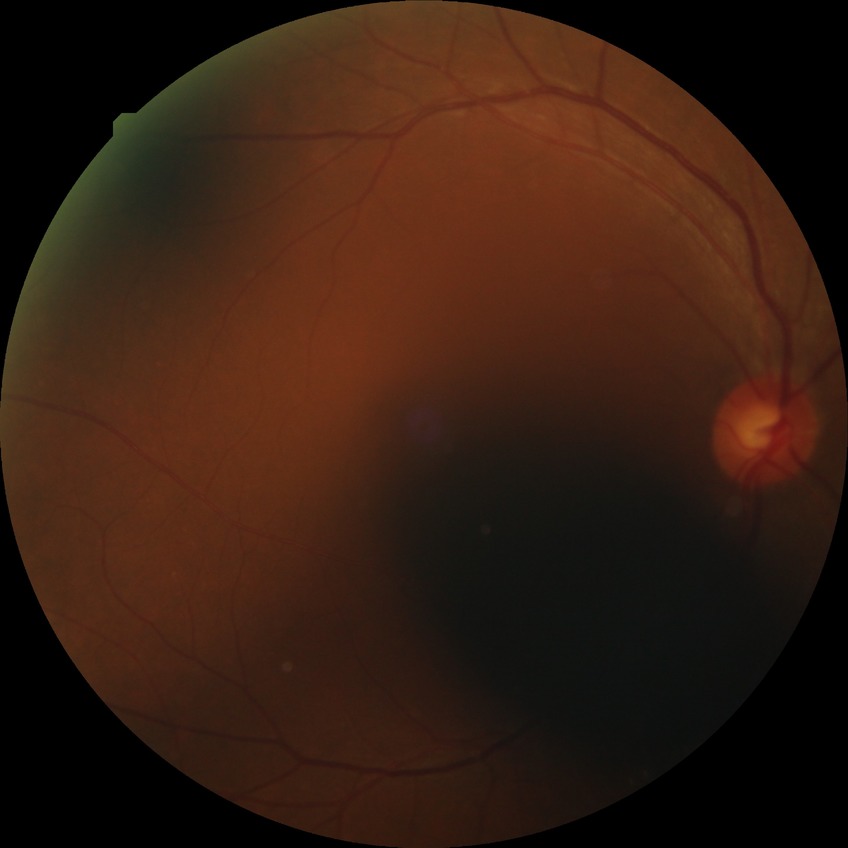
Diabetic retinopathy (DR) is SDR (simple diabetic retinopathy).